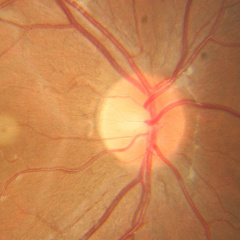

Color fundus photograph showing no glaucoma.